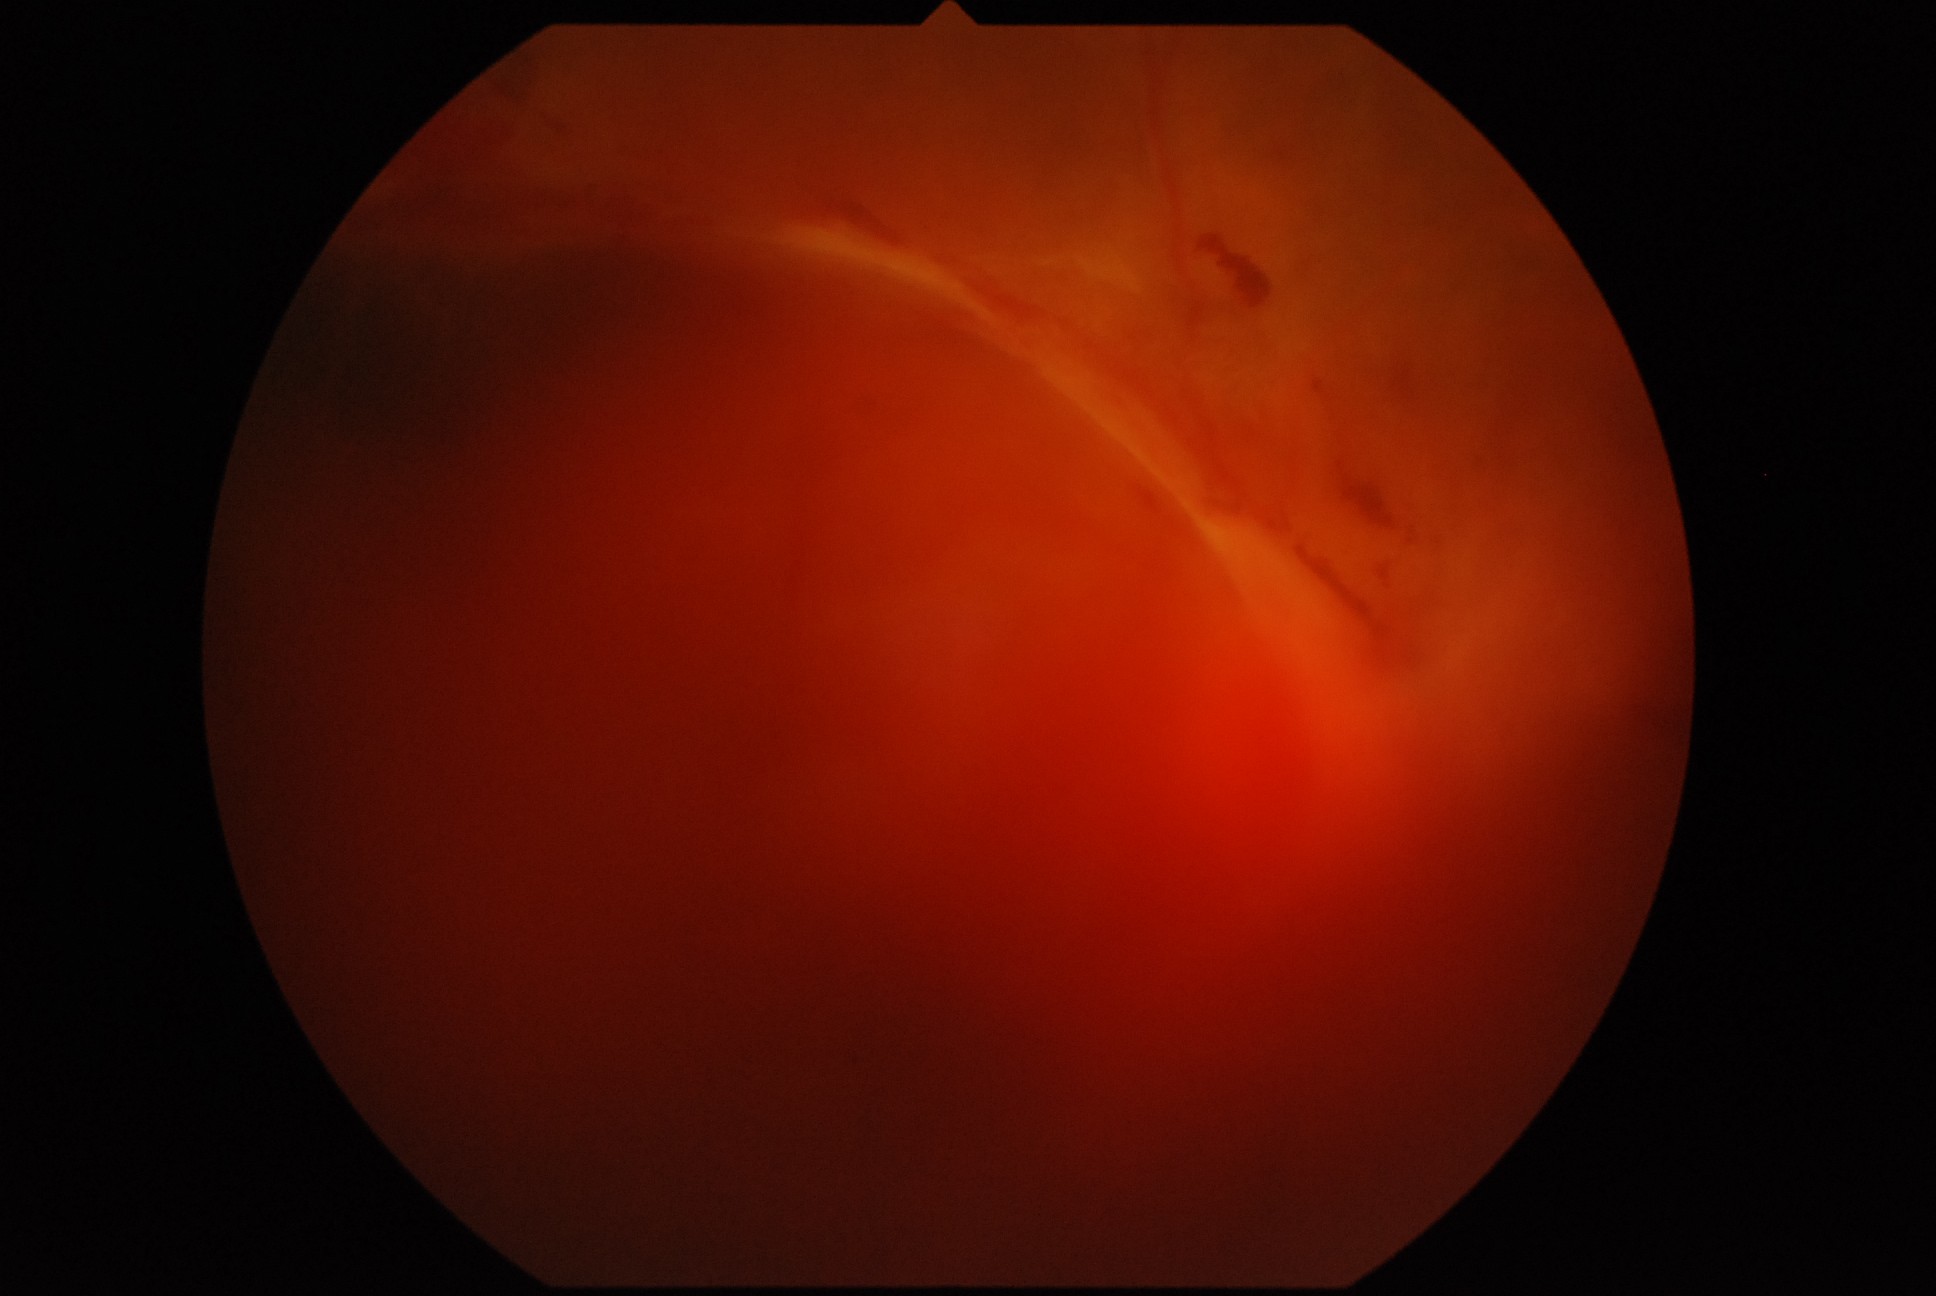
DR grade: 4.